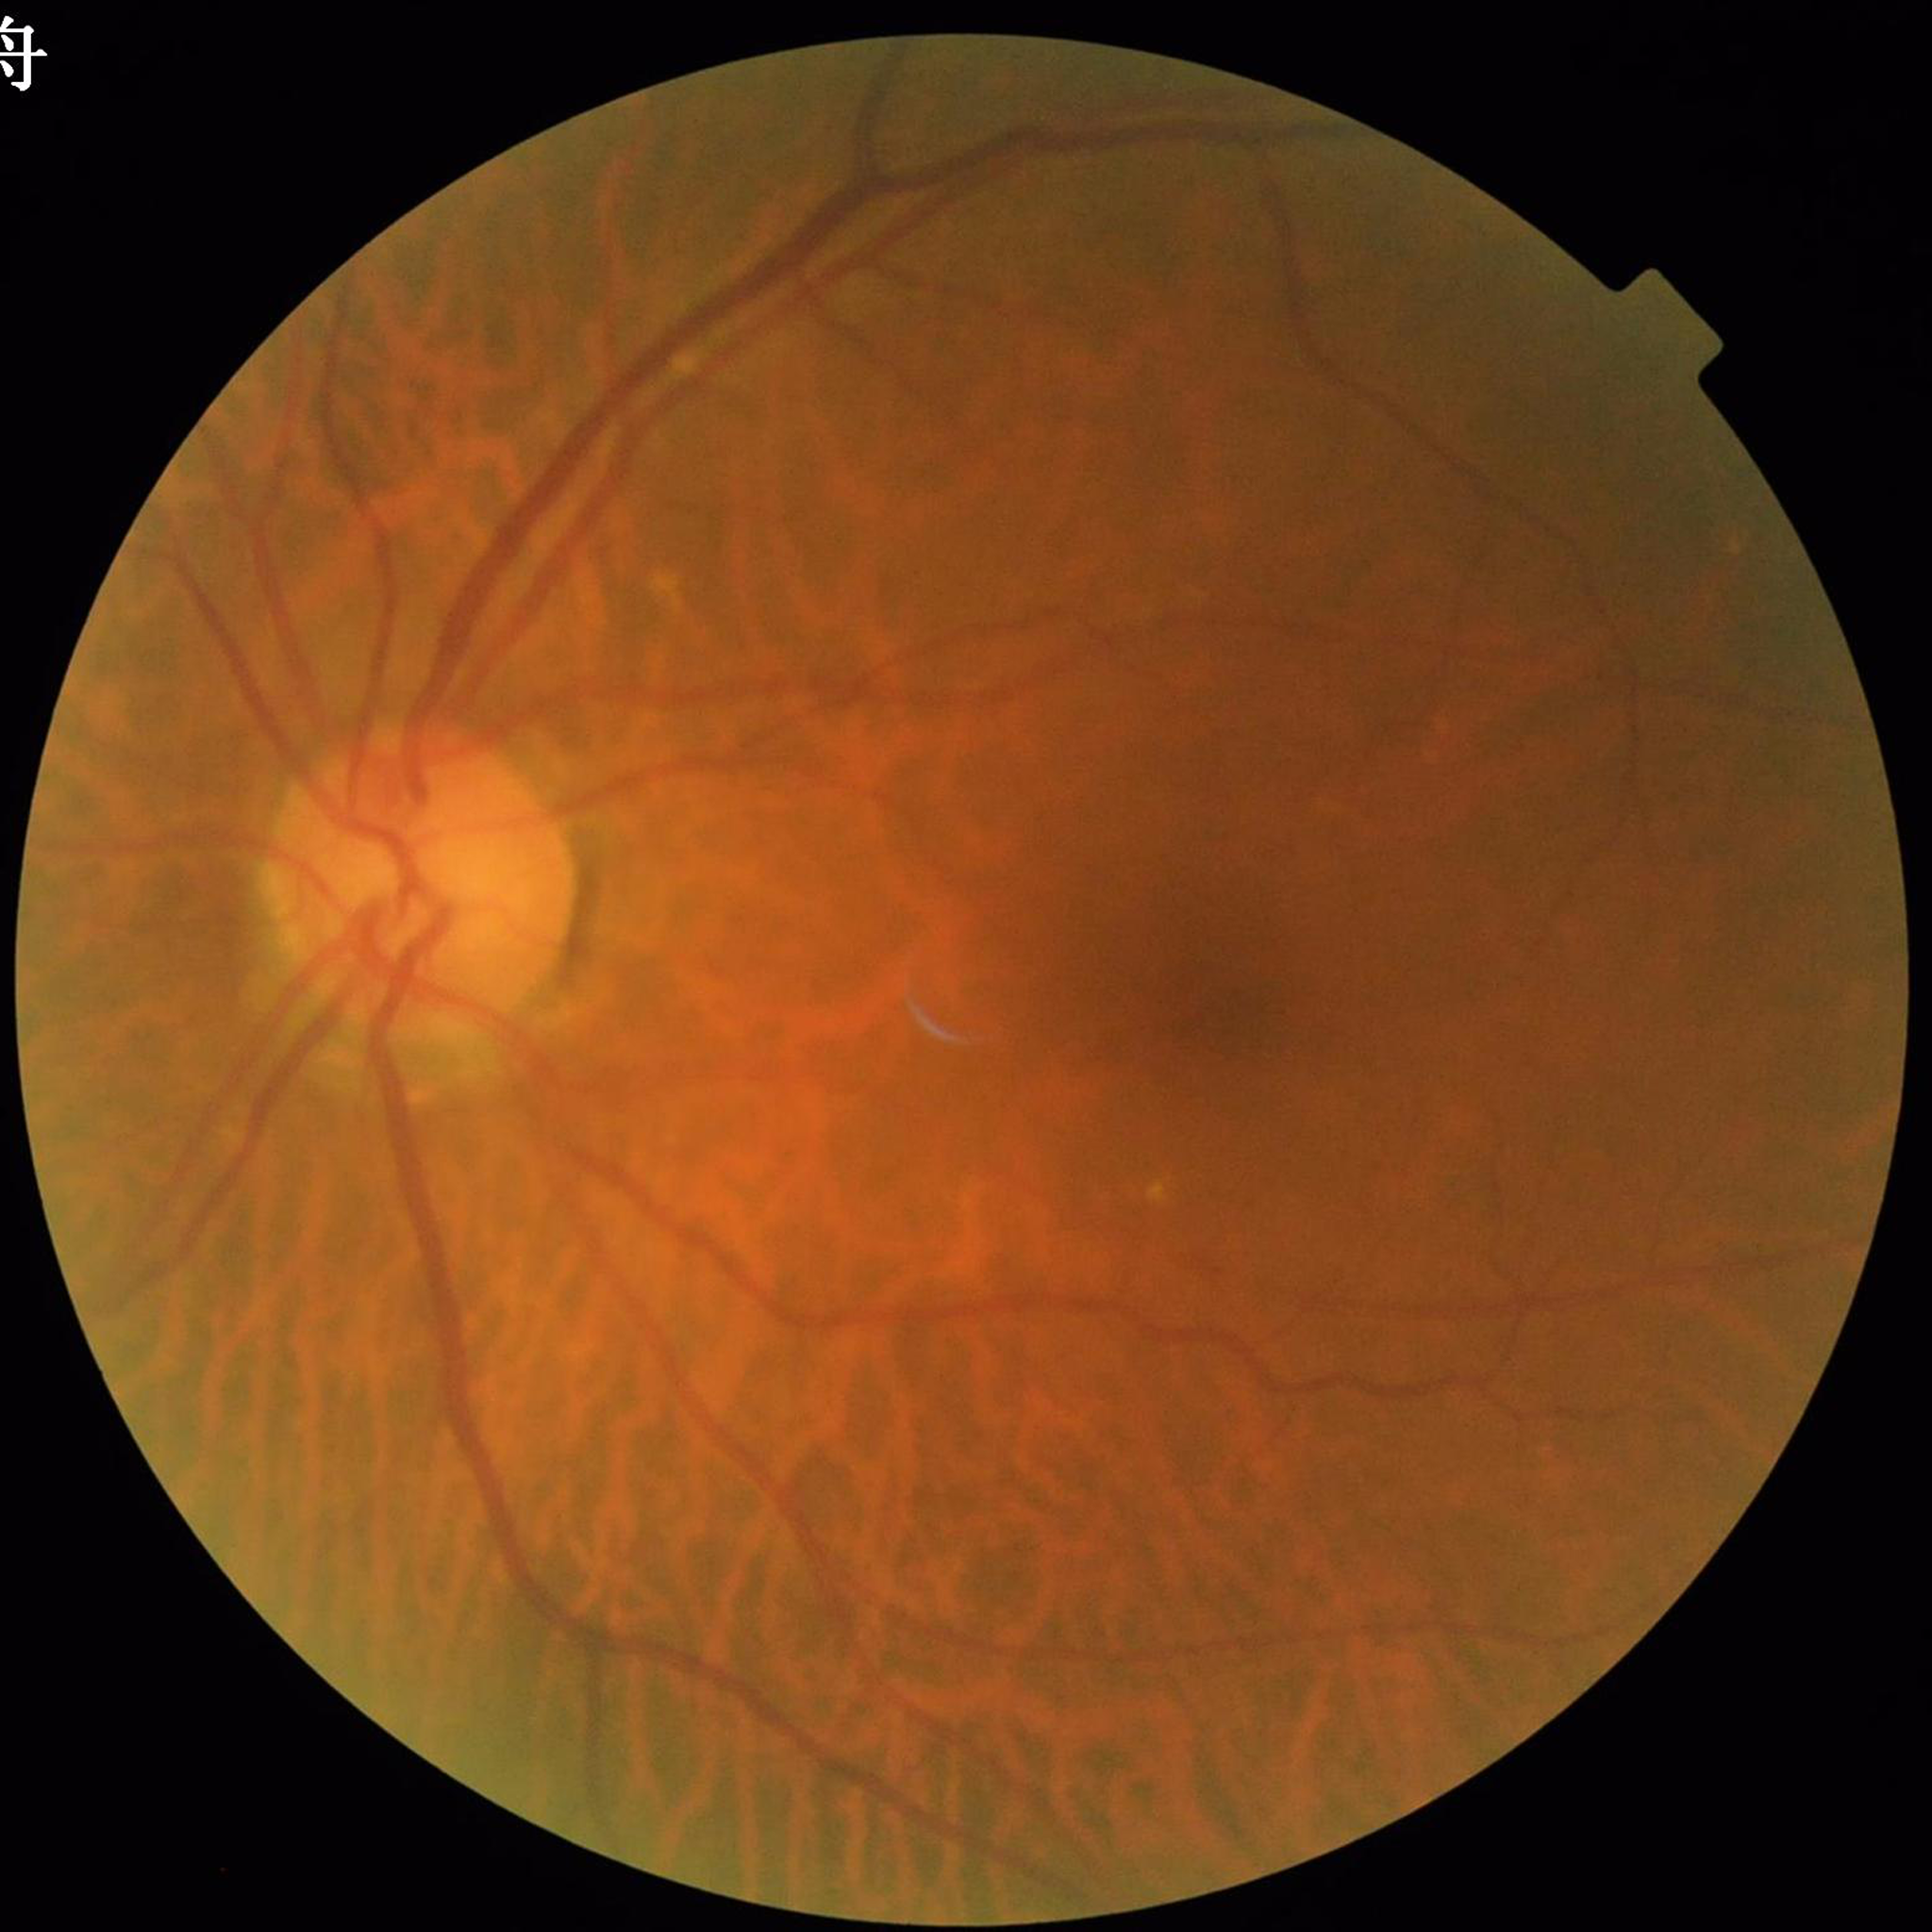
Quality assessment: poor — blur
Disease class: glaucoma